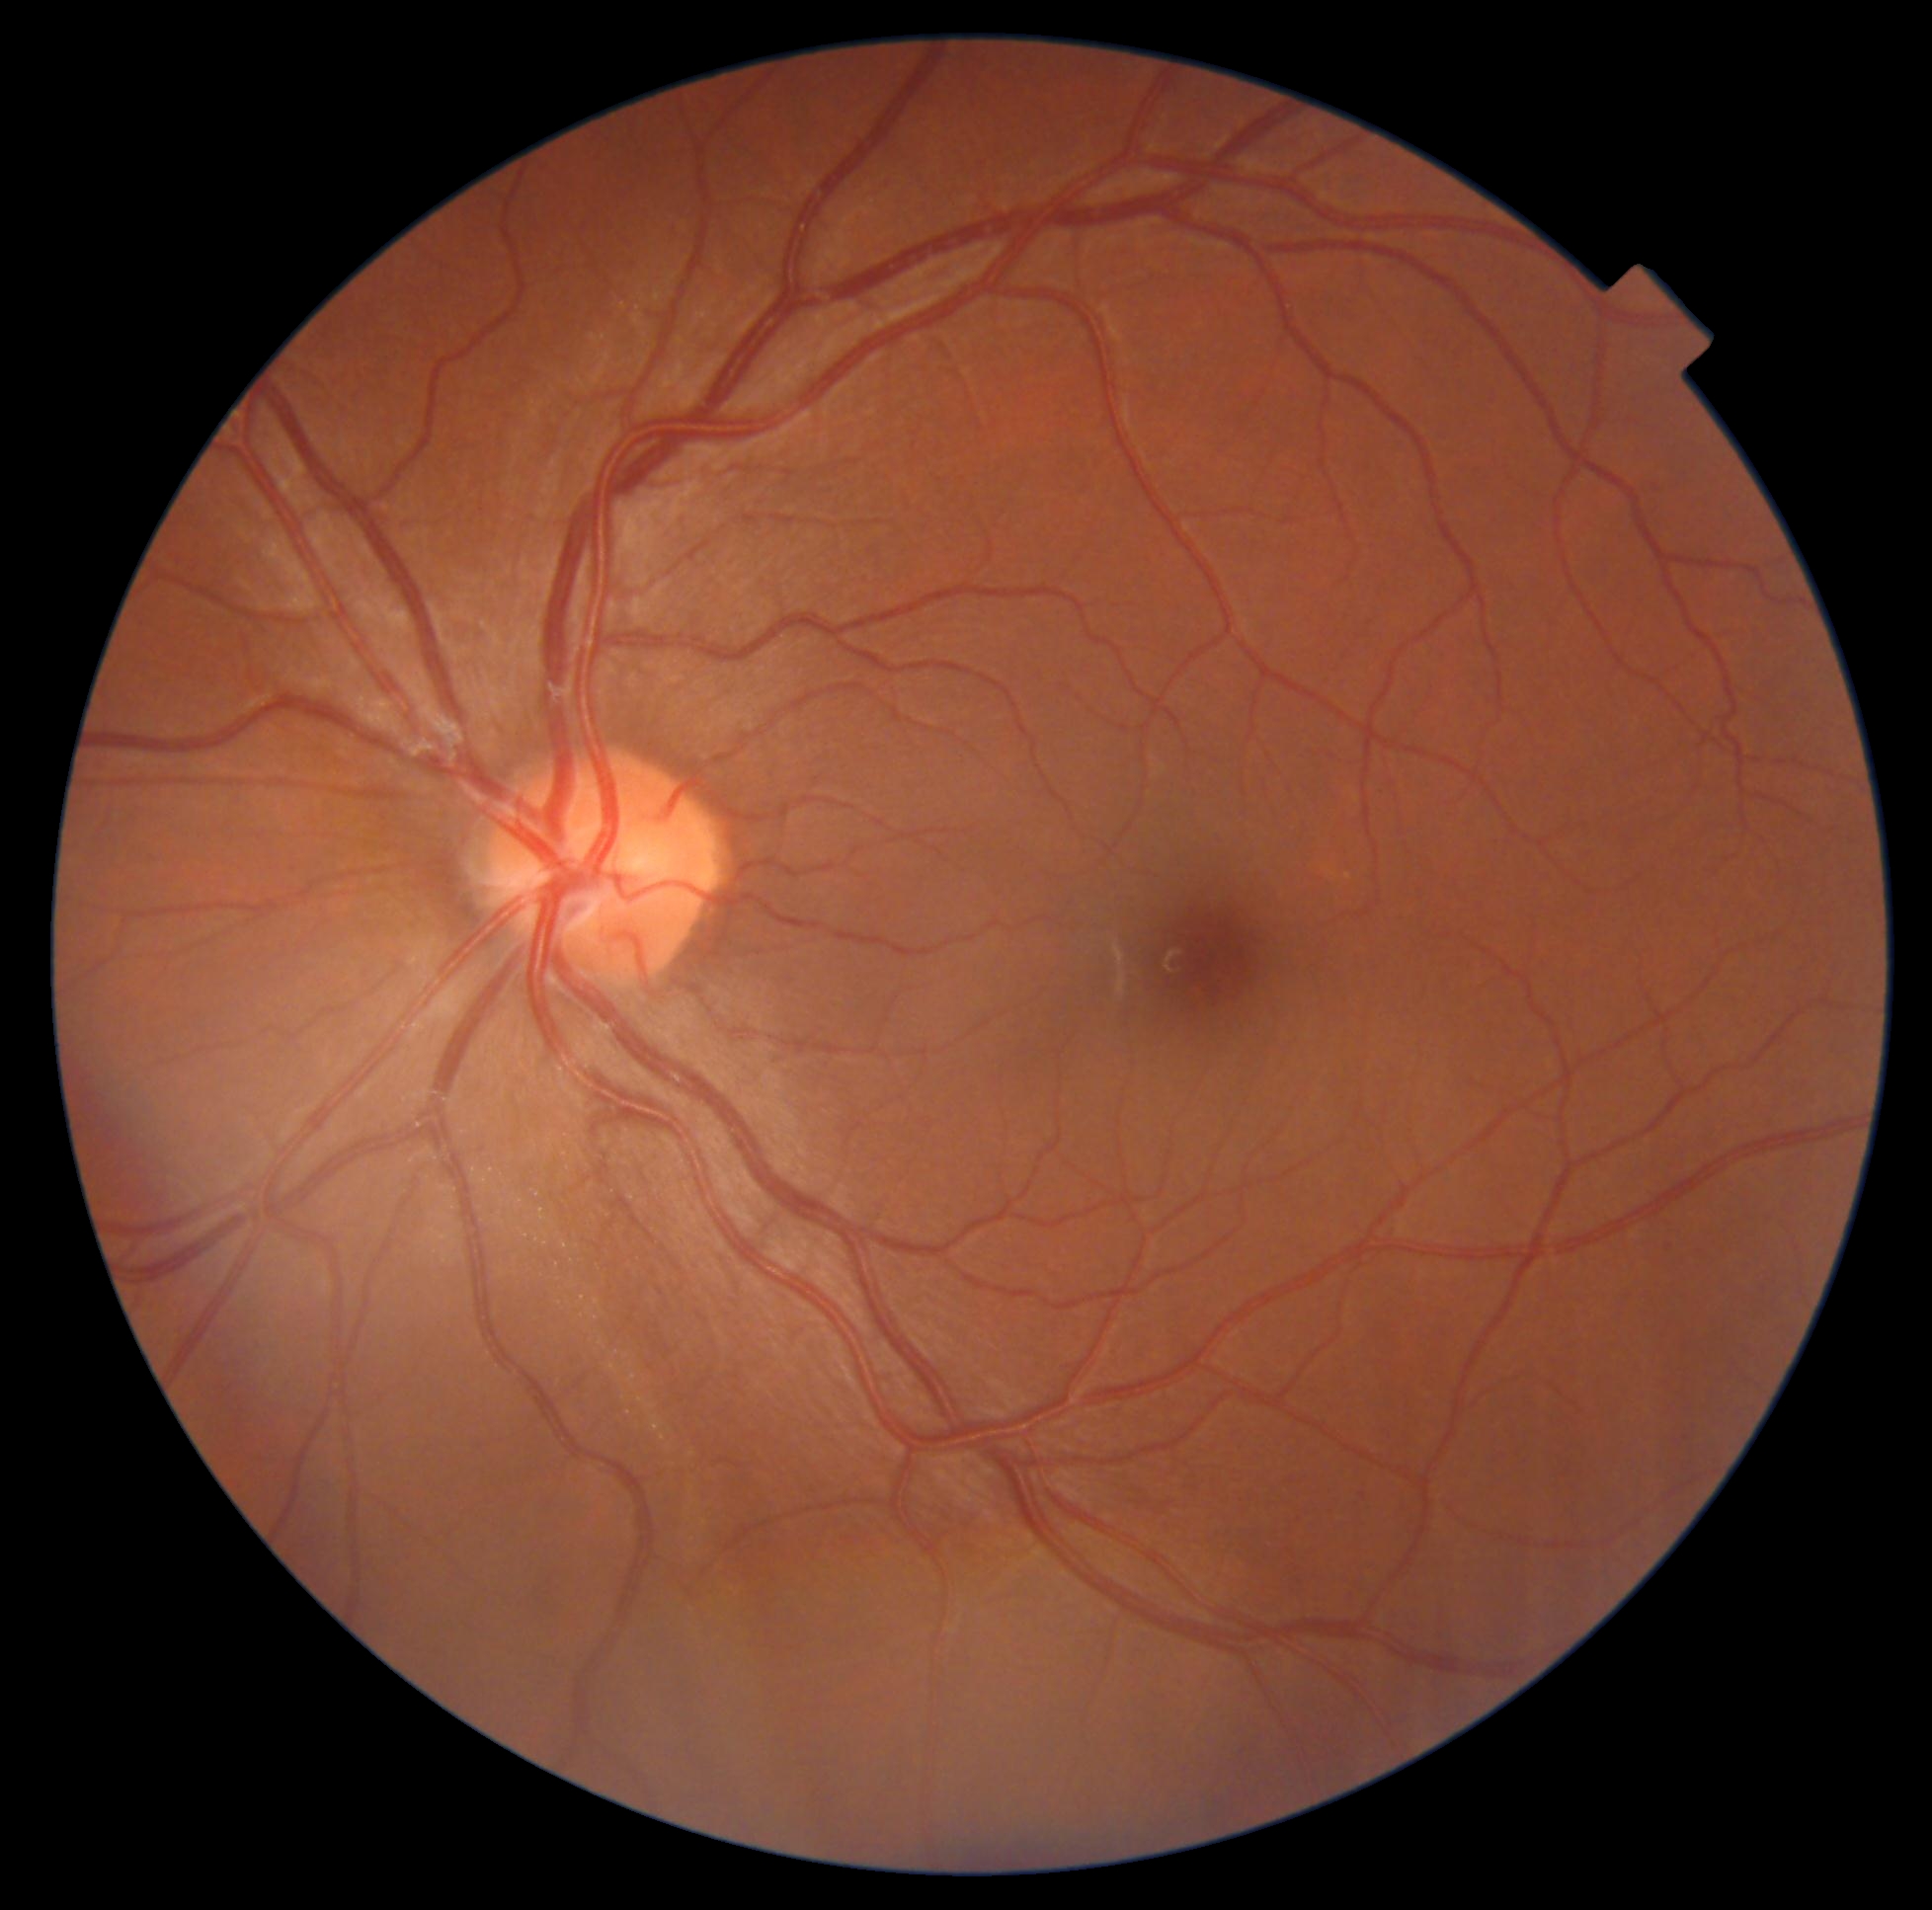

- DR impression — no signs of DR
- DR stage — no apparent retinopathy (grade 0)